1240x1240px; wide-field fundus photograph of an infant; Phoenix ICON, 100° FOV: 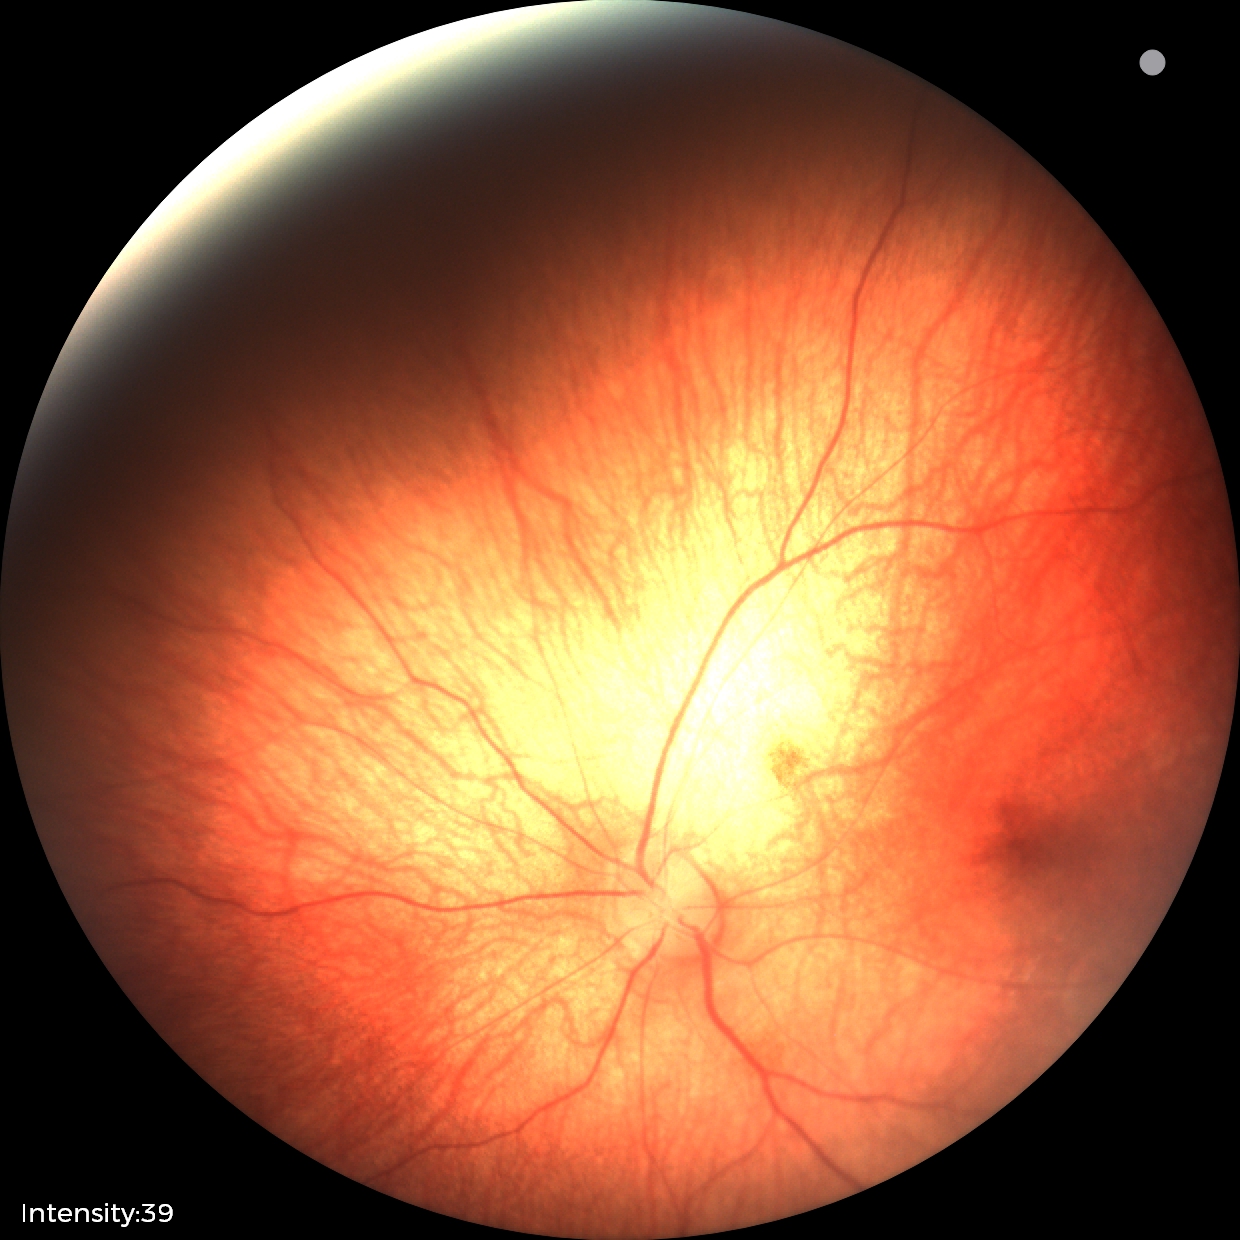 Screening diagnosis: retinal hemorrhages.